CFP:
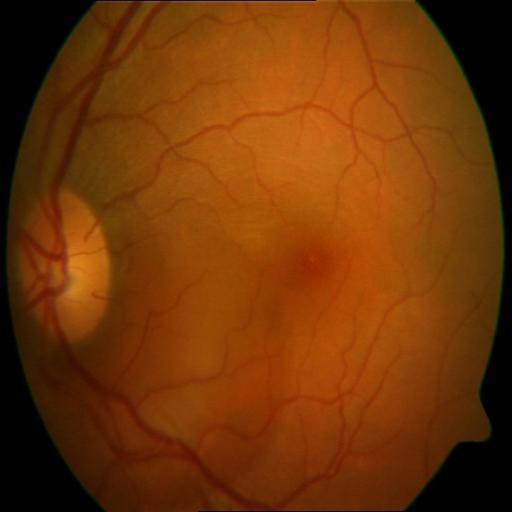 The image shows CME (cystoid macular edema).